Nonmydriatic · 45° field of view · modified Davis classification.
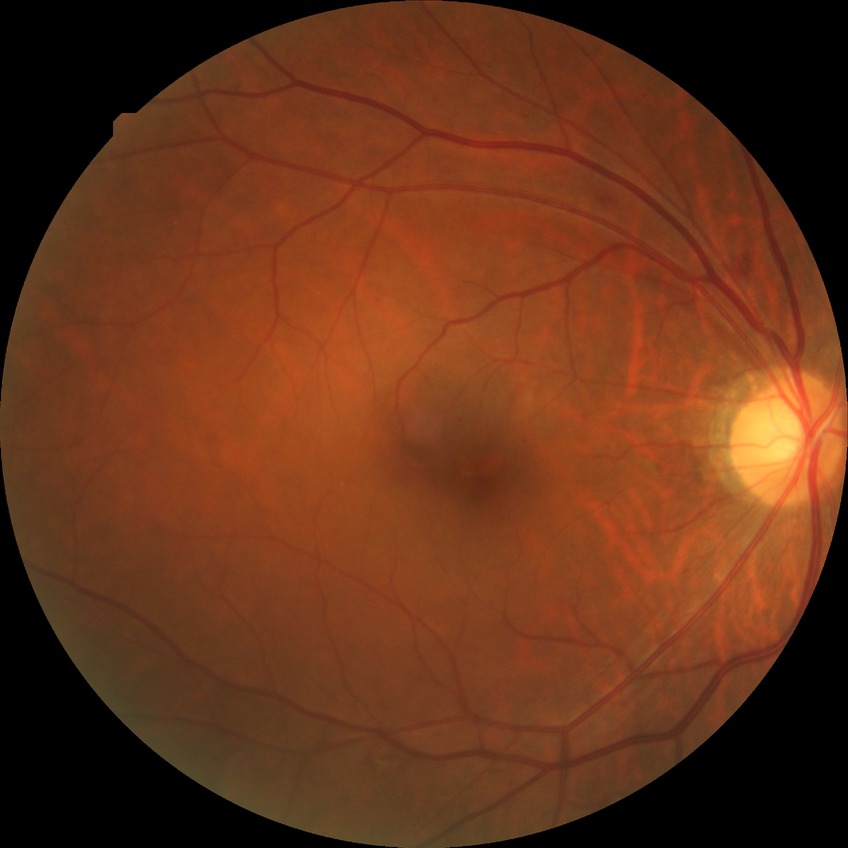 DR = SDR.